Acquired on the Clarity RetCam 3. Wide-field fundus photograph of an infant: 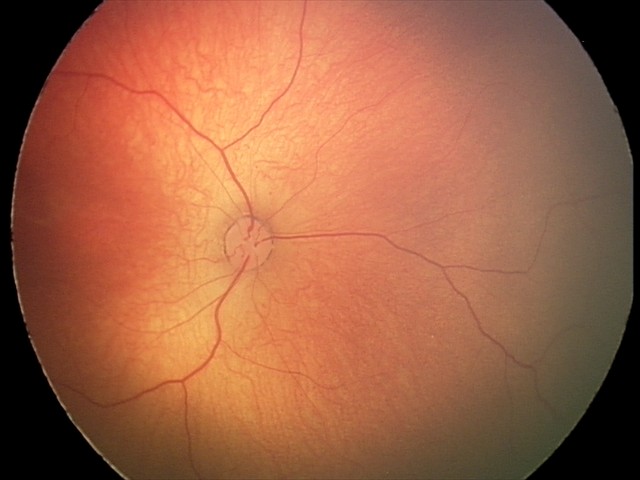 Examination with physiological retinal findings.